50° field of view — 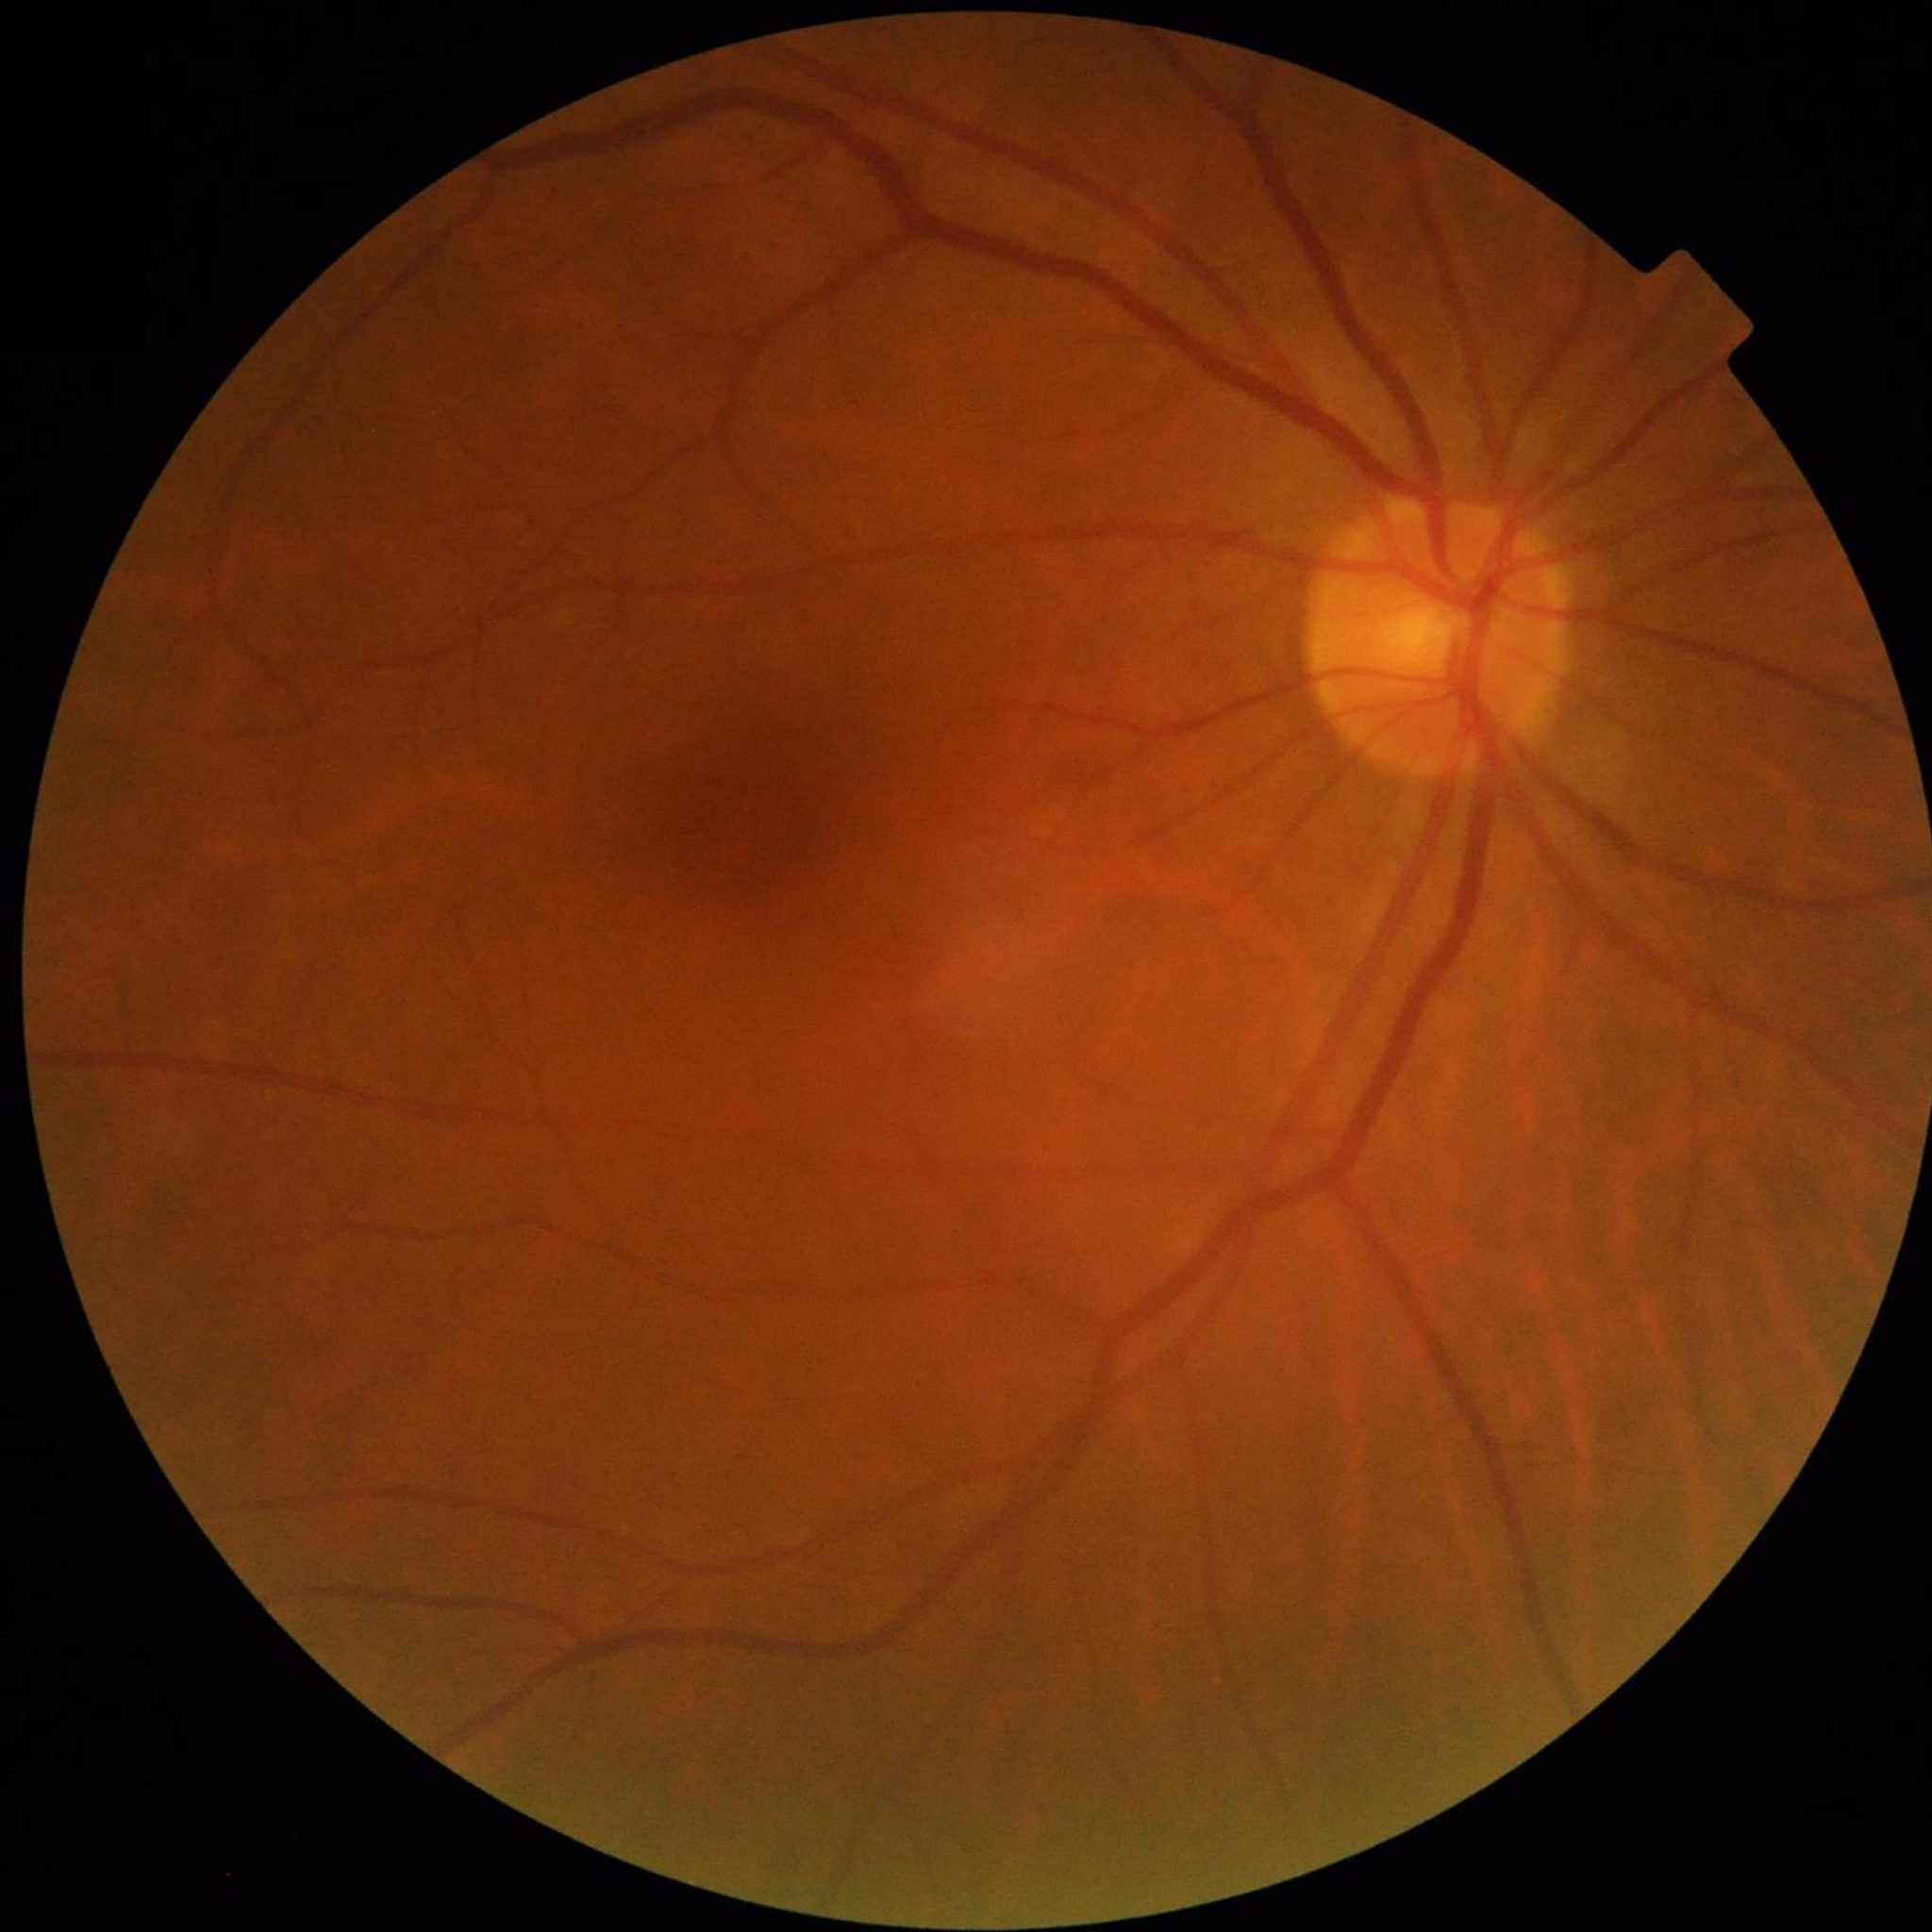

{"diagnosis": "no AMD, DR, or glaucoma"}